Retinal fundus photograph
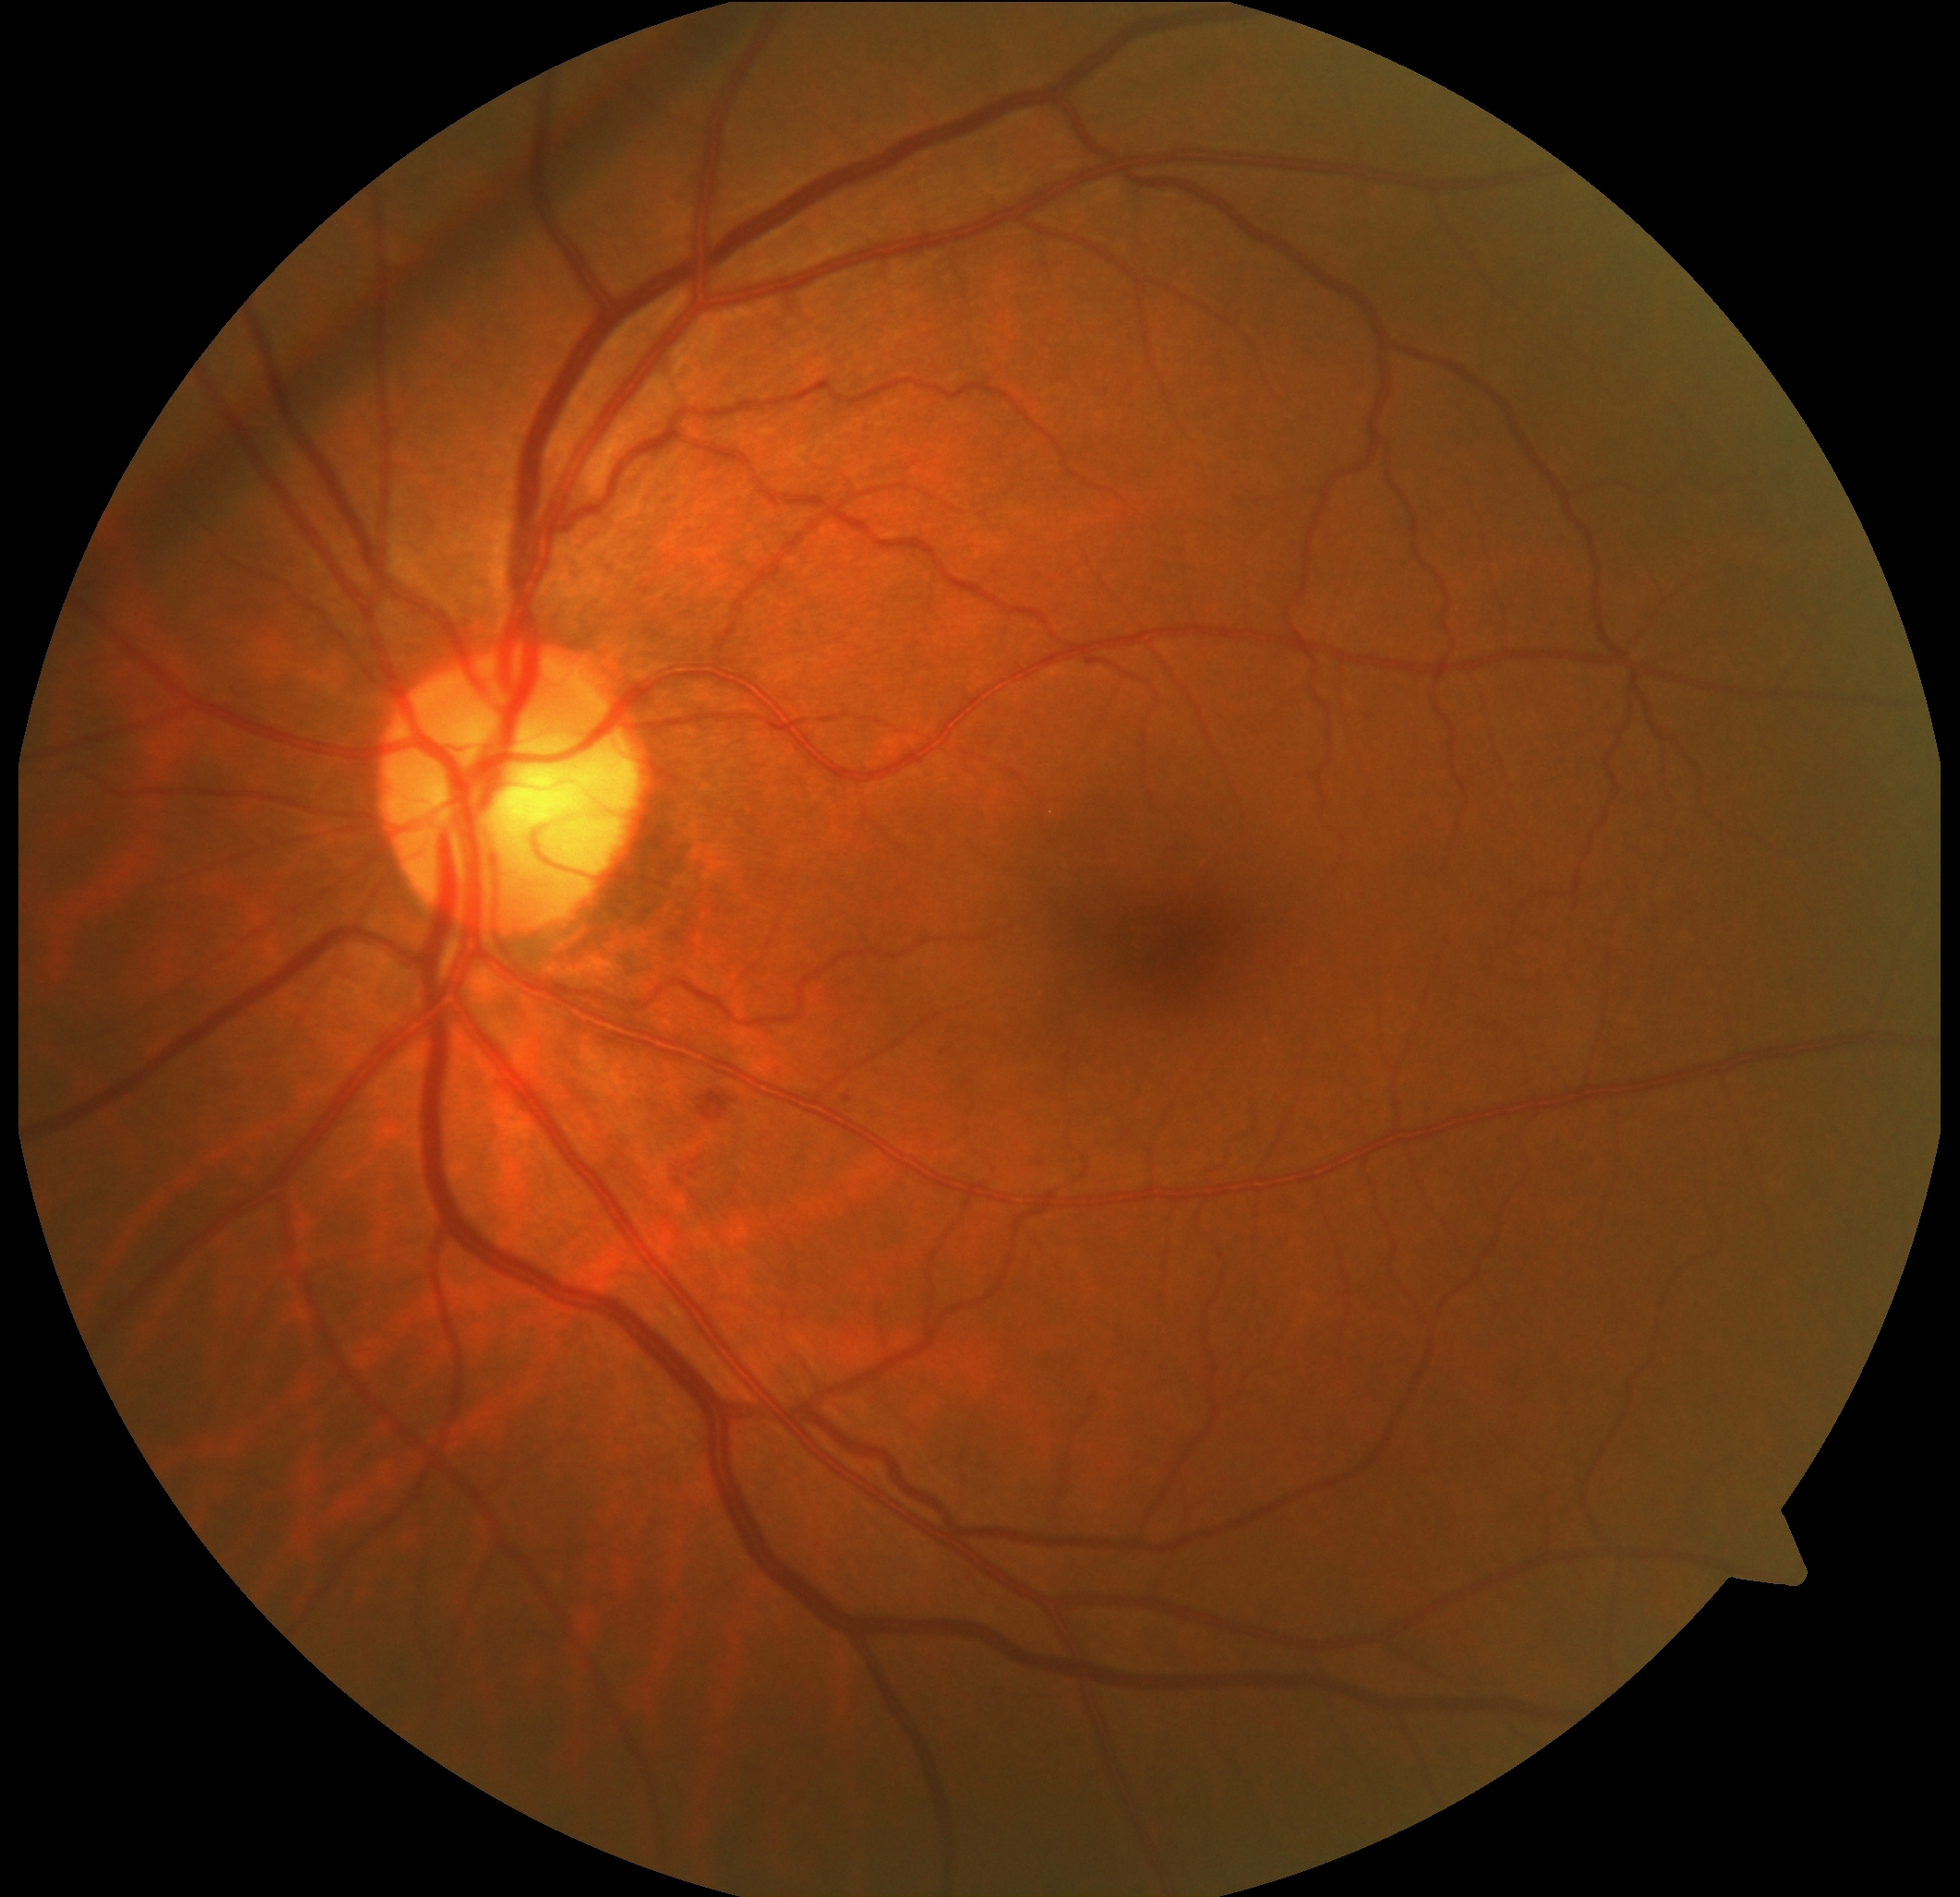 DR is 2.